CFP · 45° FOV · 2352 by 1568 pixels
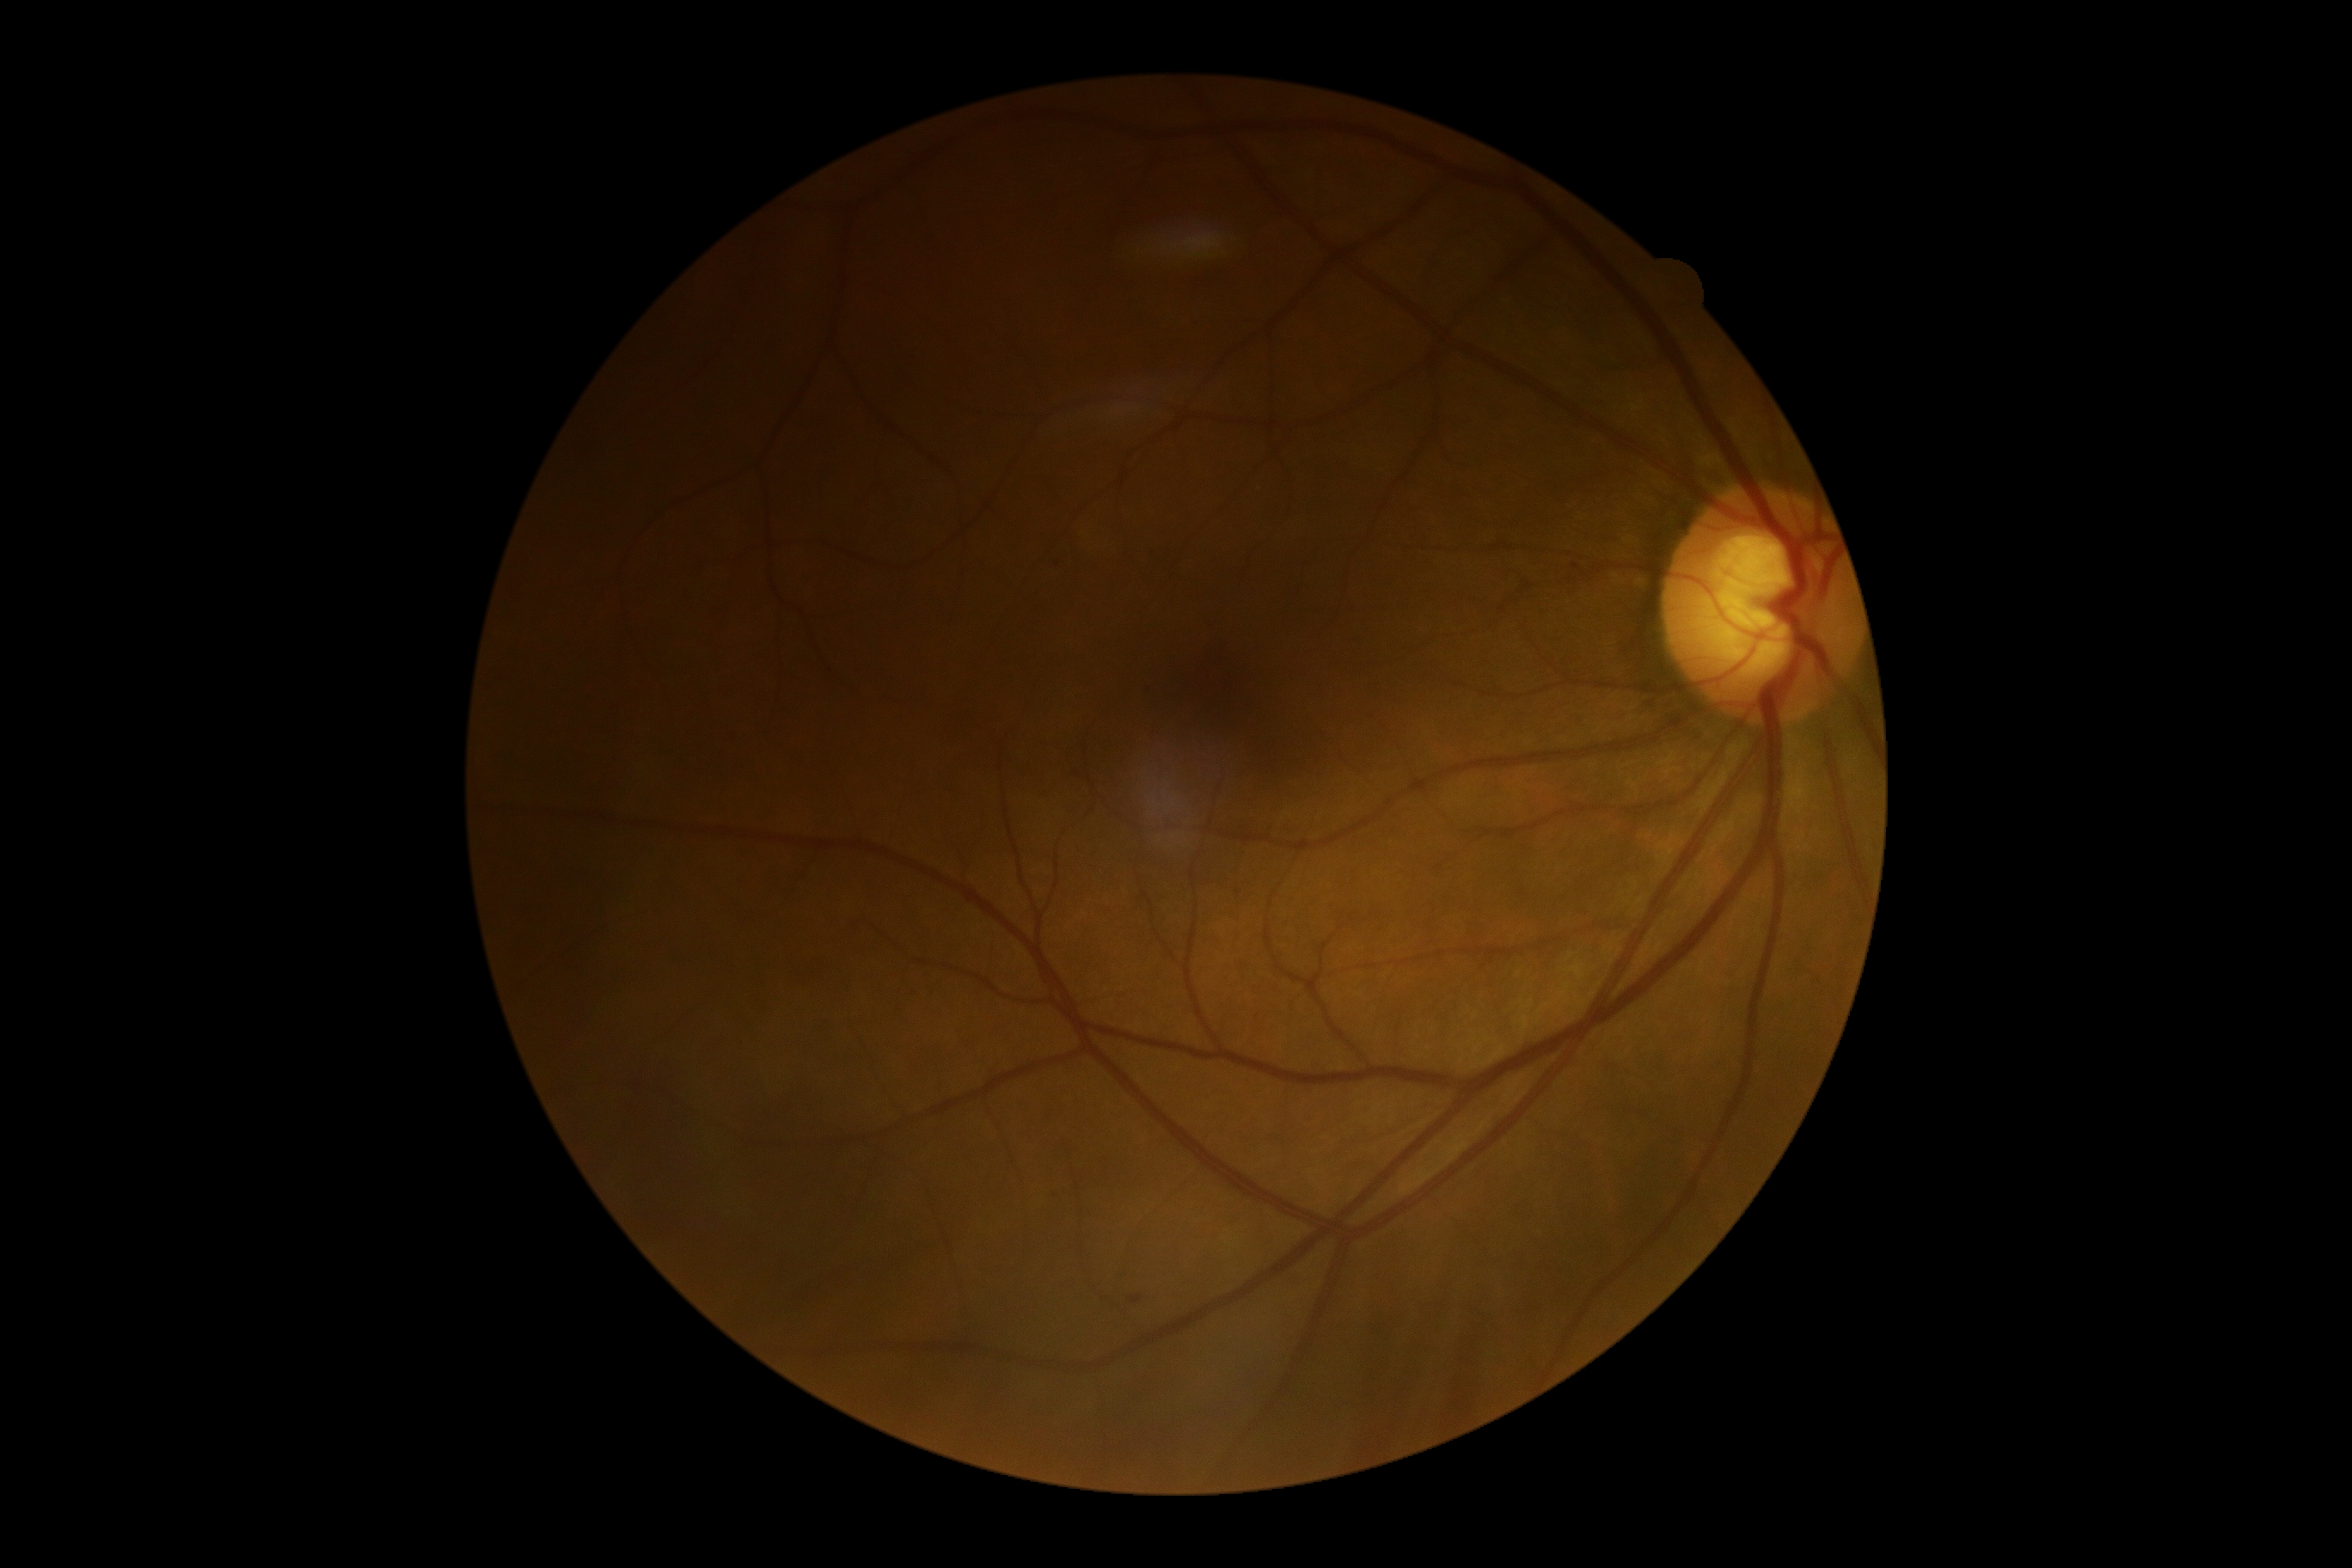

Diabetic retinopathy severity is grade 1 (mild NPDR) — presence of microaneurysms only.